848 by 848 pixels · without pupil dilation · 45° field of view.
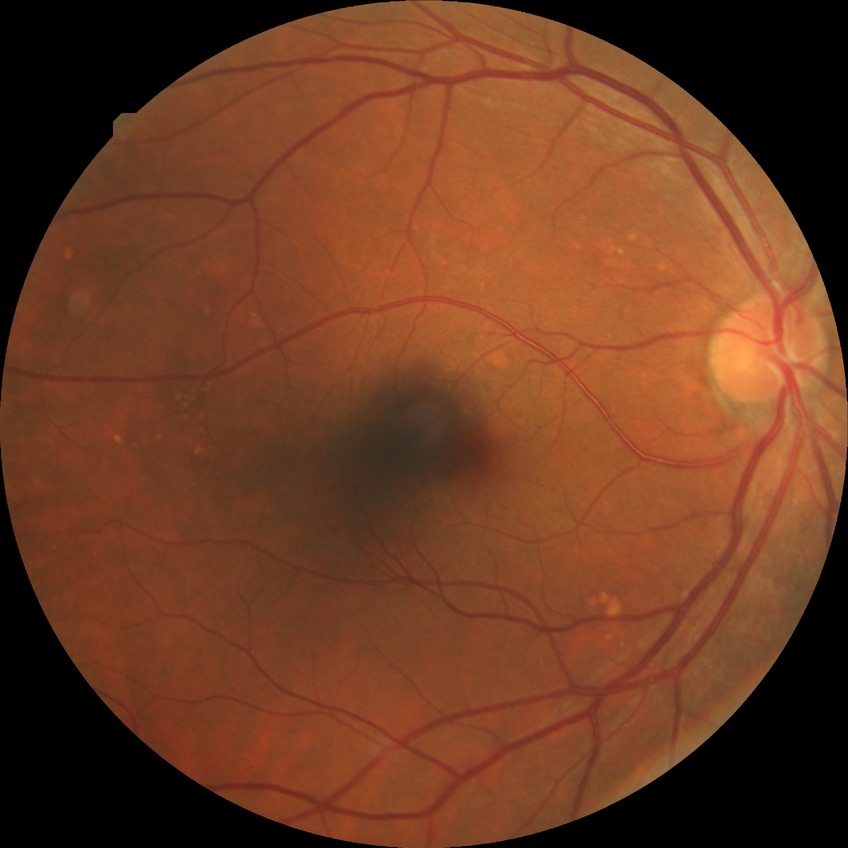

Diabetic retinopathy (DR): no diabetic retinopathy (NDR).